45° FOV: 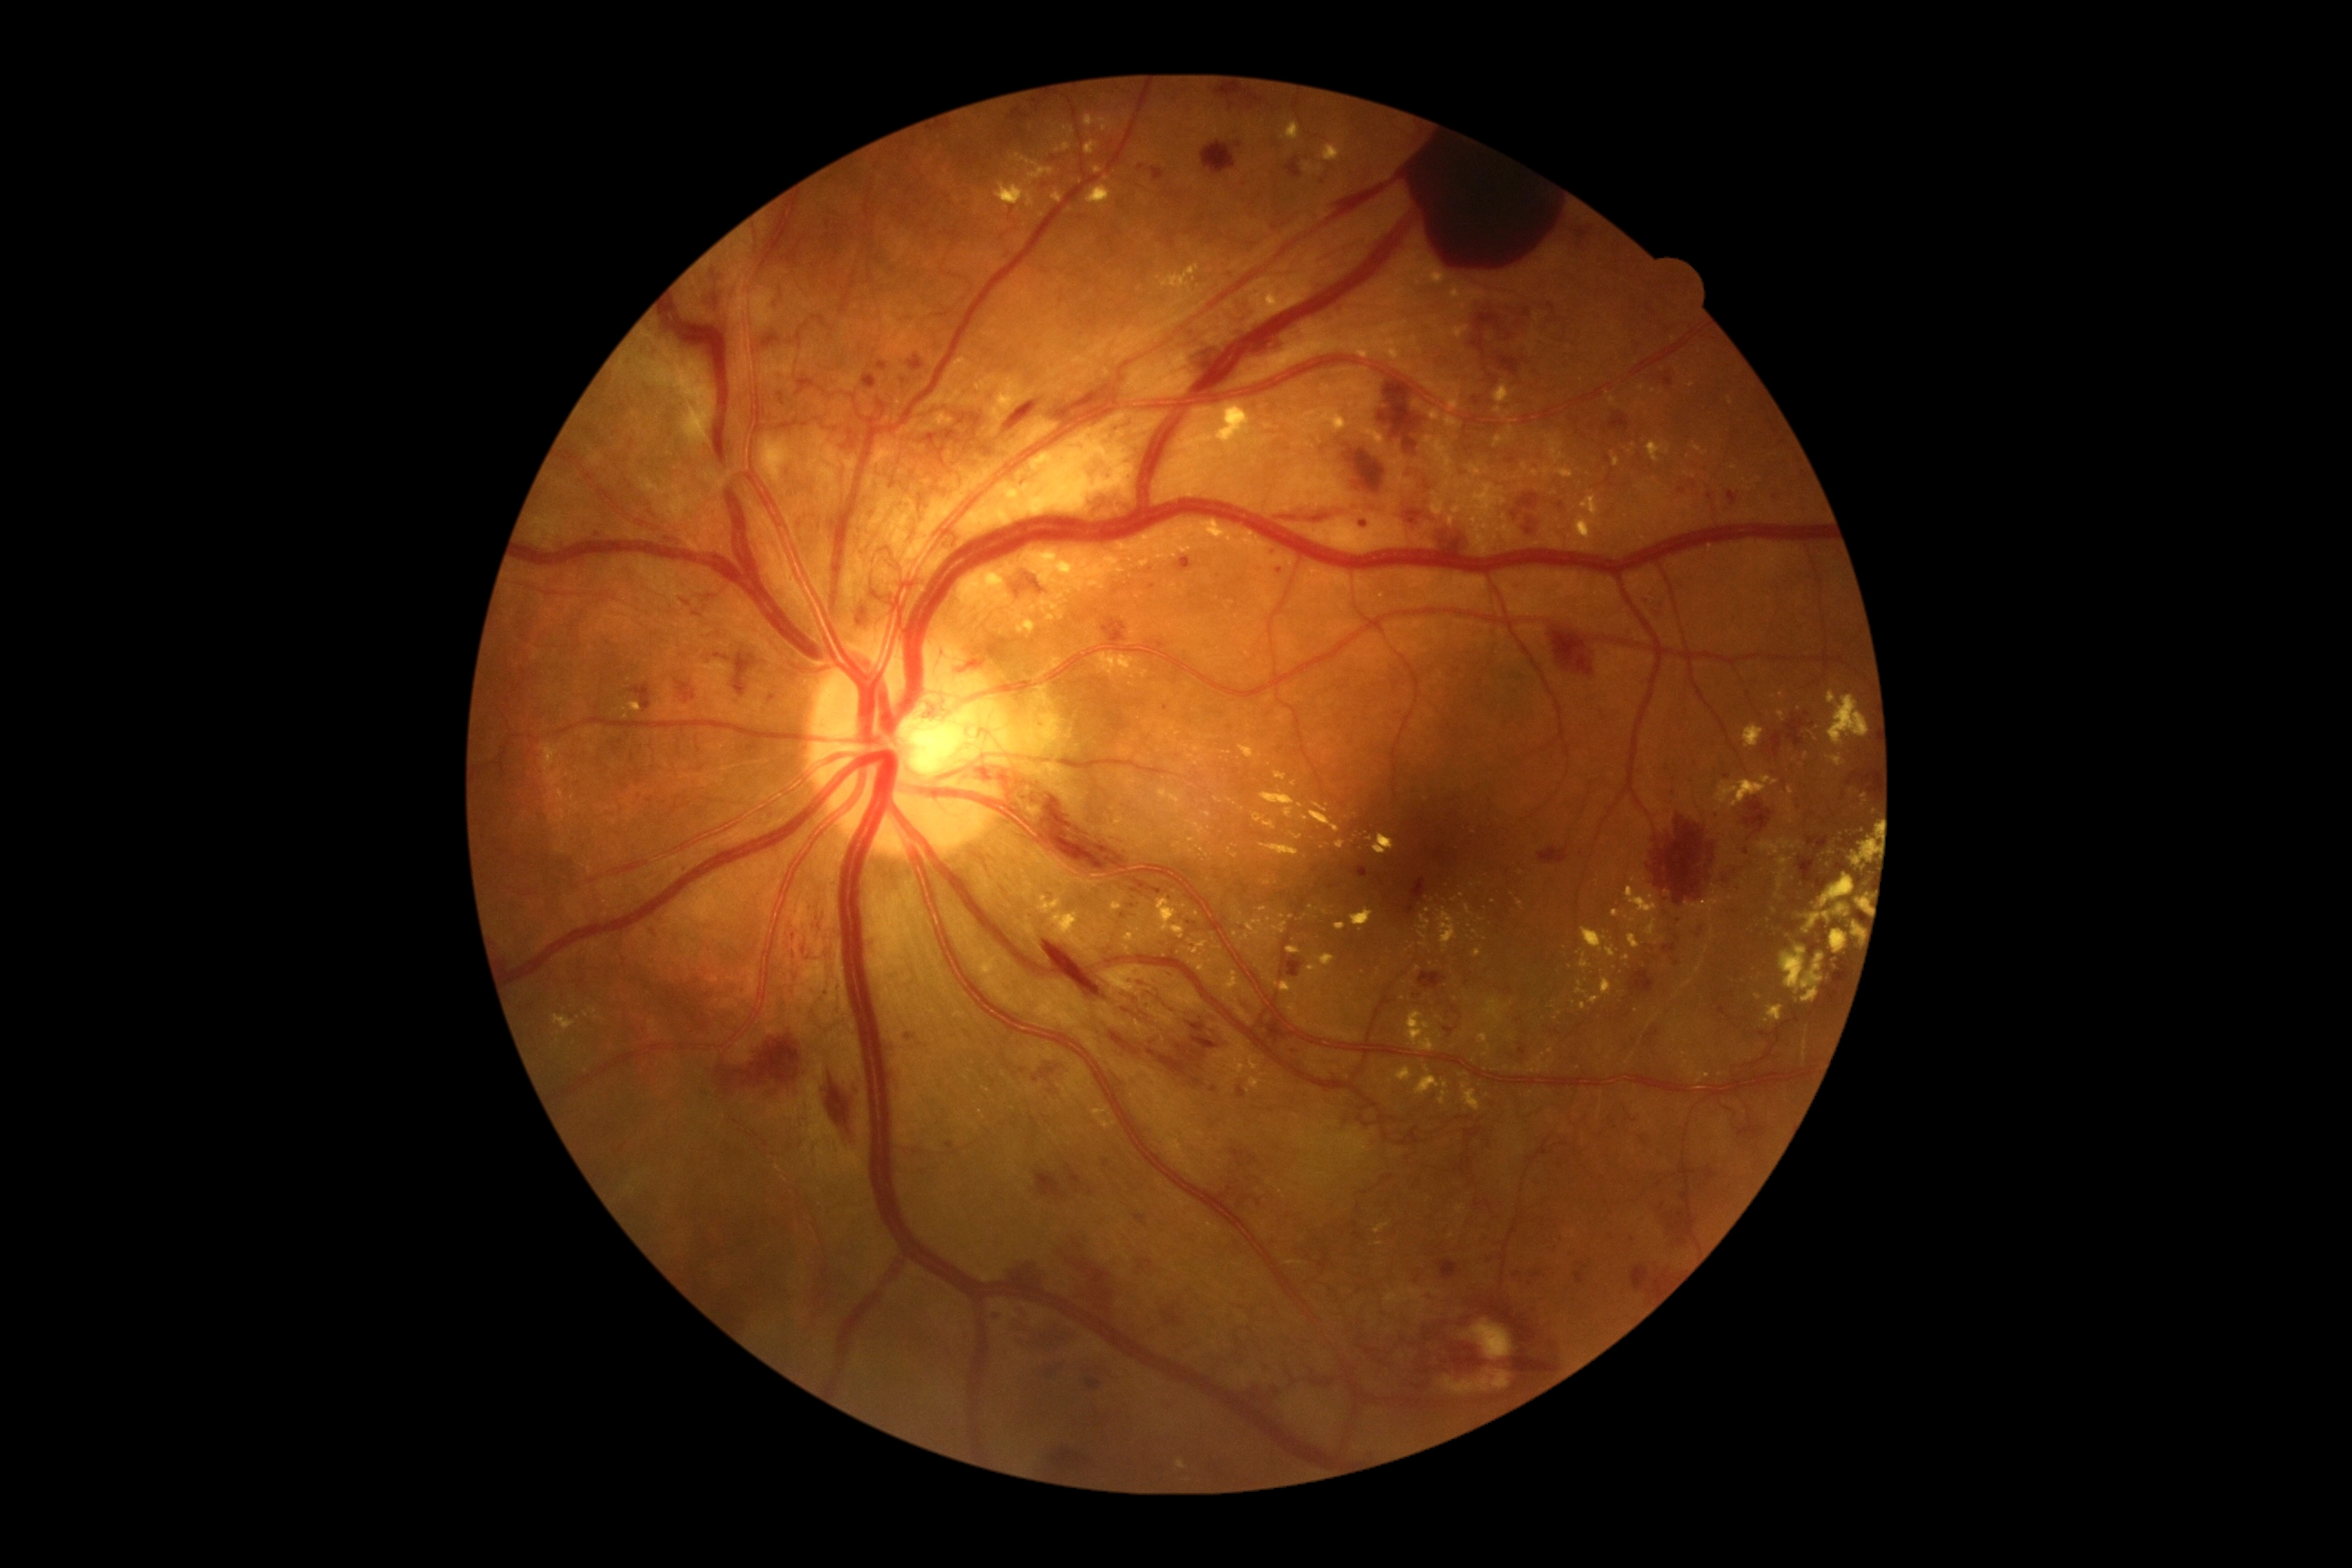
{"partial":true,"dr_grade":4,"dr_grade_name":"PDR","lesions":{"he":[[856,605,870,636],[1043,941,1230,1090],[1538,847,1569,865],[1353,867,1369,877],[1054,1447,1099,1471],[1291,1048,1302,1055],[692,612,701,618],[850,1079,863,1102],[1525,529,1534,536],[1779,941,1792,950],[678,863,689,876],[1161,1300,1190,1329],[1070,1404,1126,1442],[1150,168,1166,182],[952,643,1003,672]],"he_small":[[1681,491],[1872,791],[1677,938]],"ex":[[629,703,642,712],[1061,582,1070,587],[1411,337,1418,346],[1576,981,1589,997],[1449,282,1487,311],[959,571,1010,605],[1260,906,1268,912],[1023,551,1119,591],[1373,834,1395,856],[1179,821,1208,843],[1607,948,1616,959],[1282,122,1300,142],[1313,803,1328,814]],"ex_small":[[1155,813],[1653,392],[1378,1081],[1019,618],[559,1032],[1634,445]]}}